45-degree field of view. Color fundus photograph. 1932 by 1932 pixels — 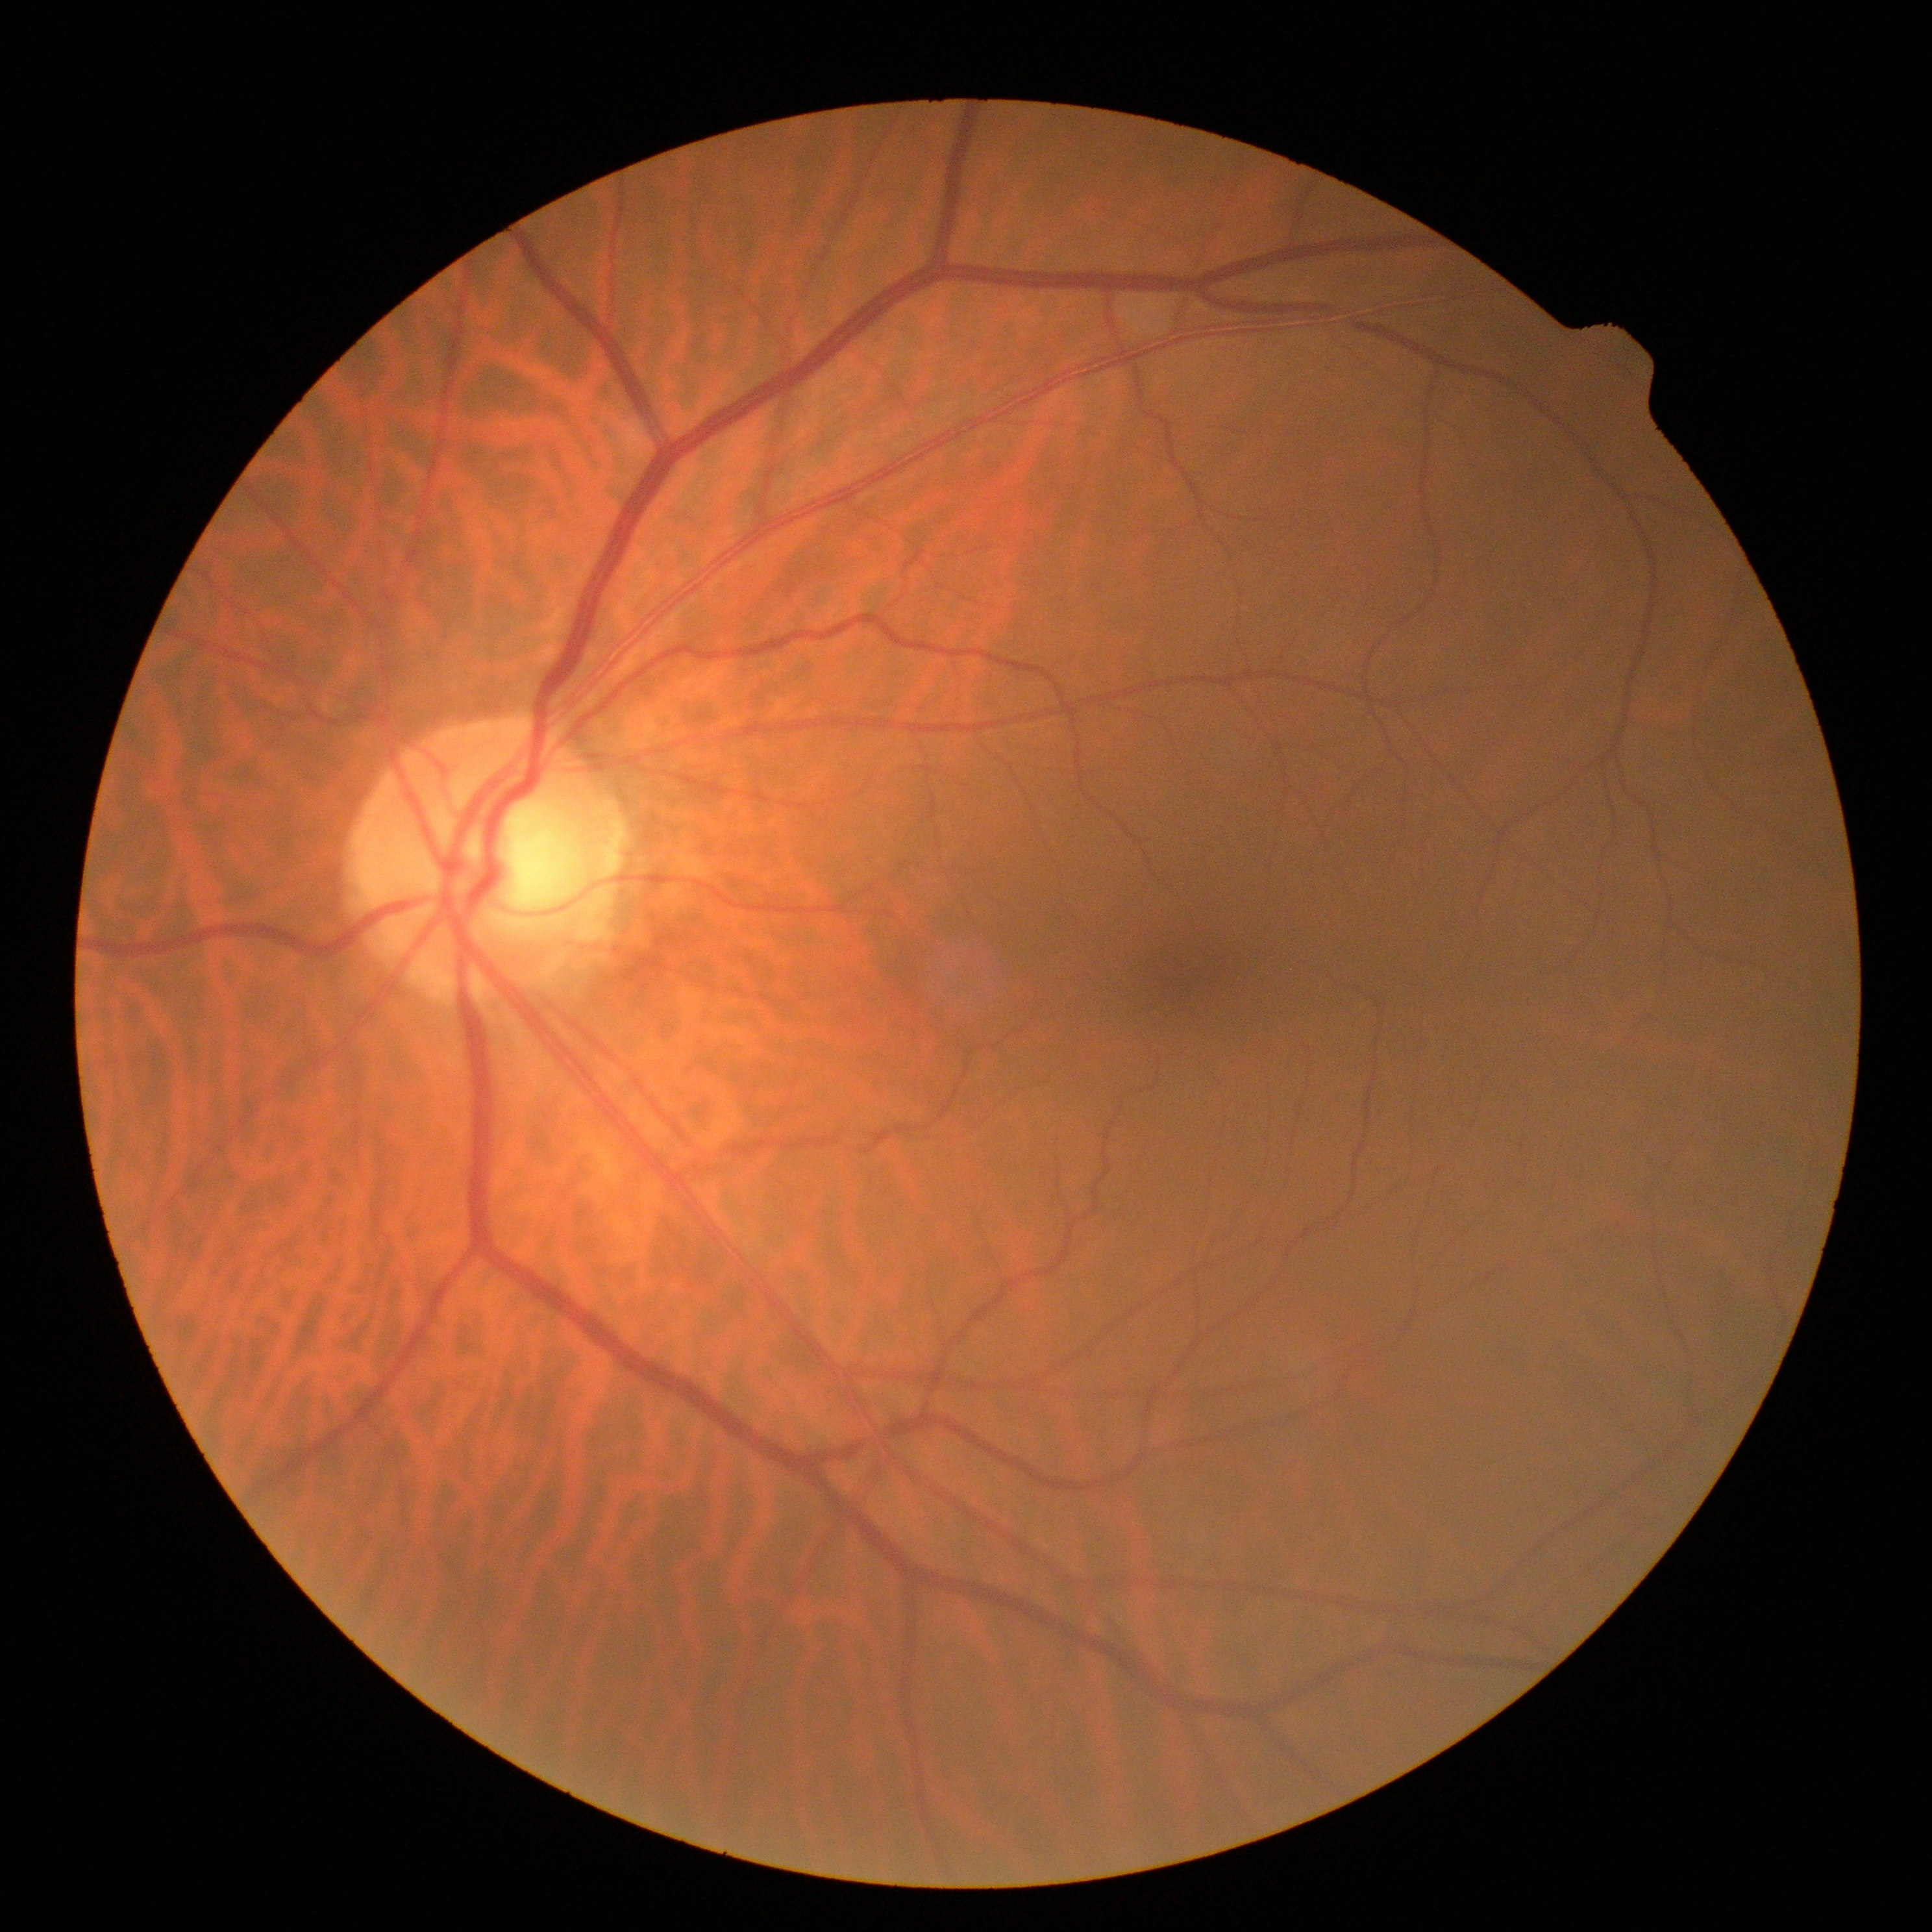
Retinopathy grade is 0/4.